240x240 · non-mydriatic · camera: Nidek AFC-330: 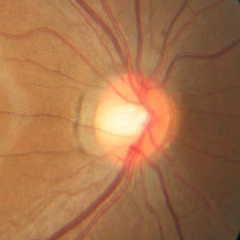
No glaucomatous changes.